1960x1897px:
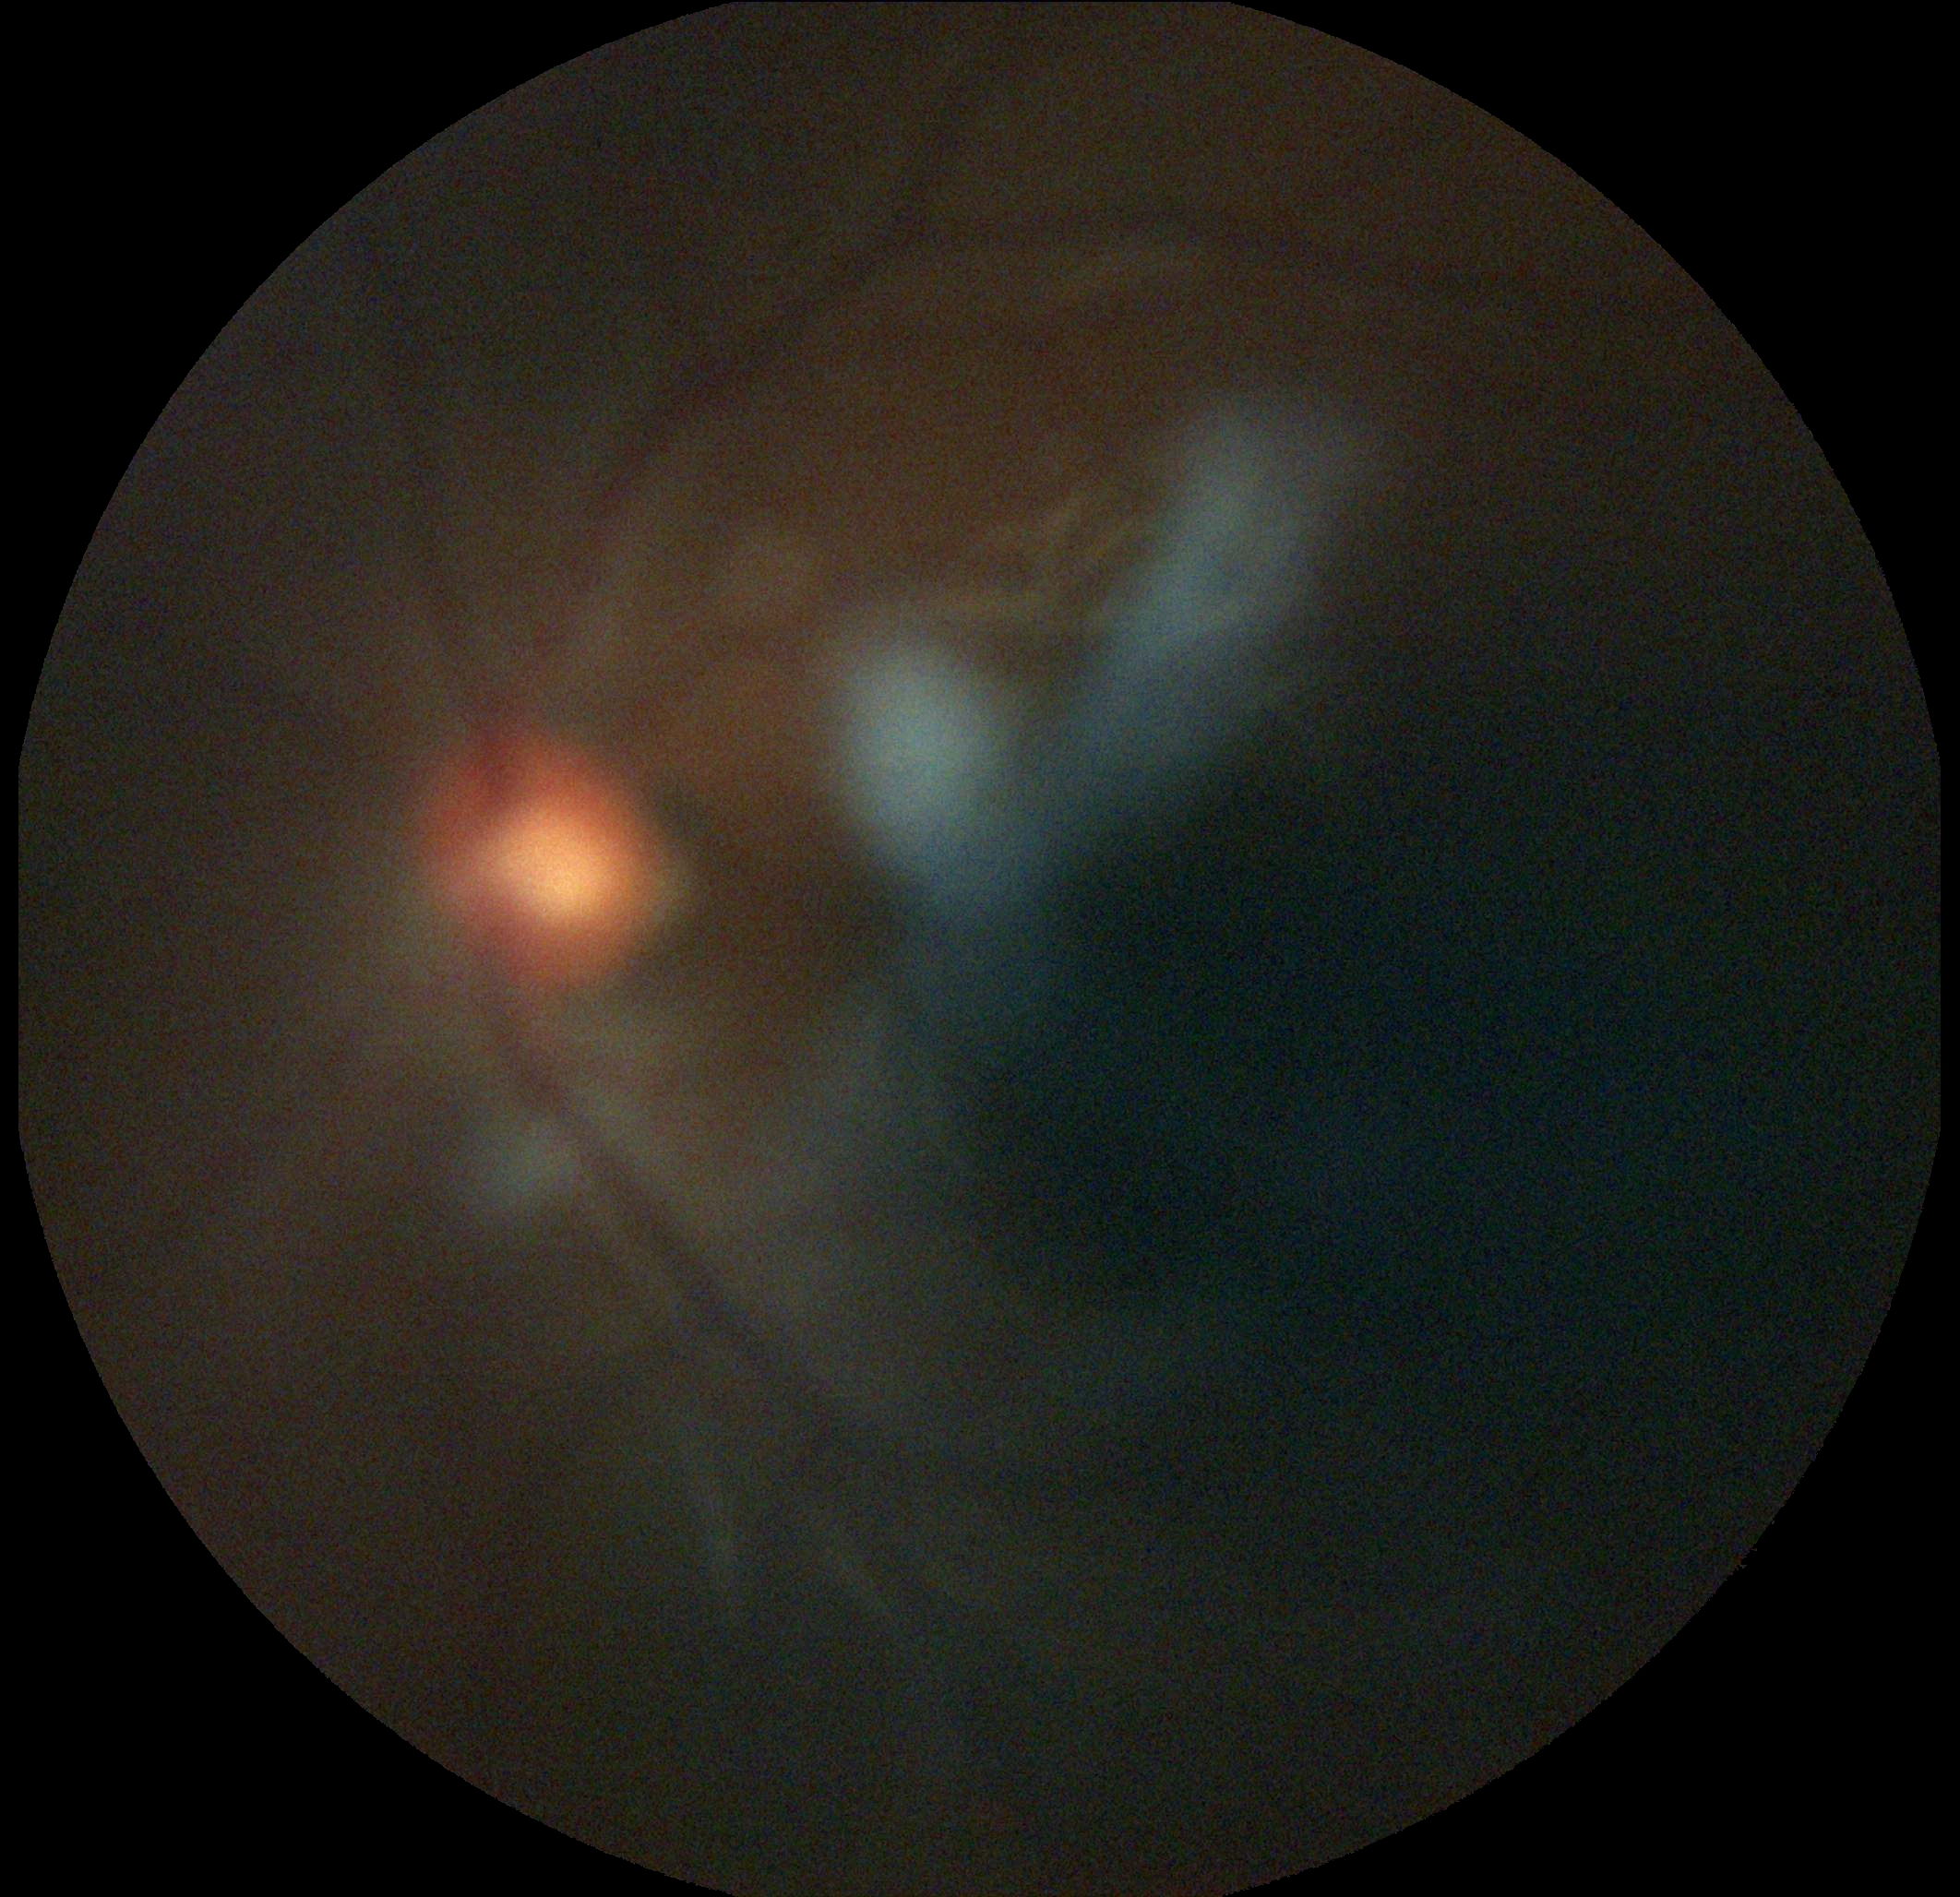
The image cannot be graded for diabetic retinopathy.
DR severity: ungradable.